Pupil-dilated · macula at the center of the field · 50° FOV · color fundus image.
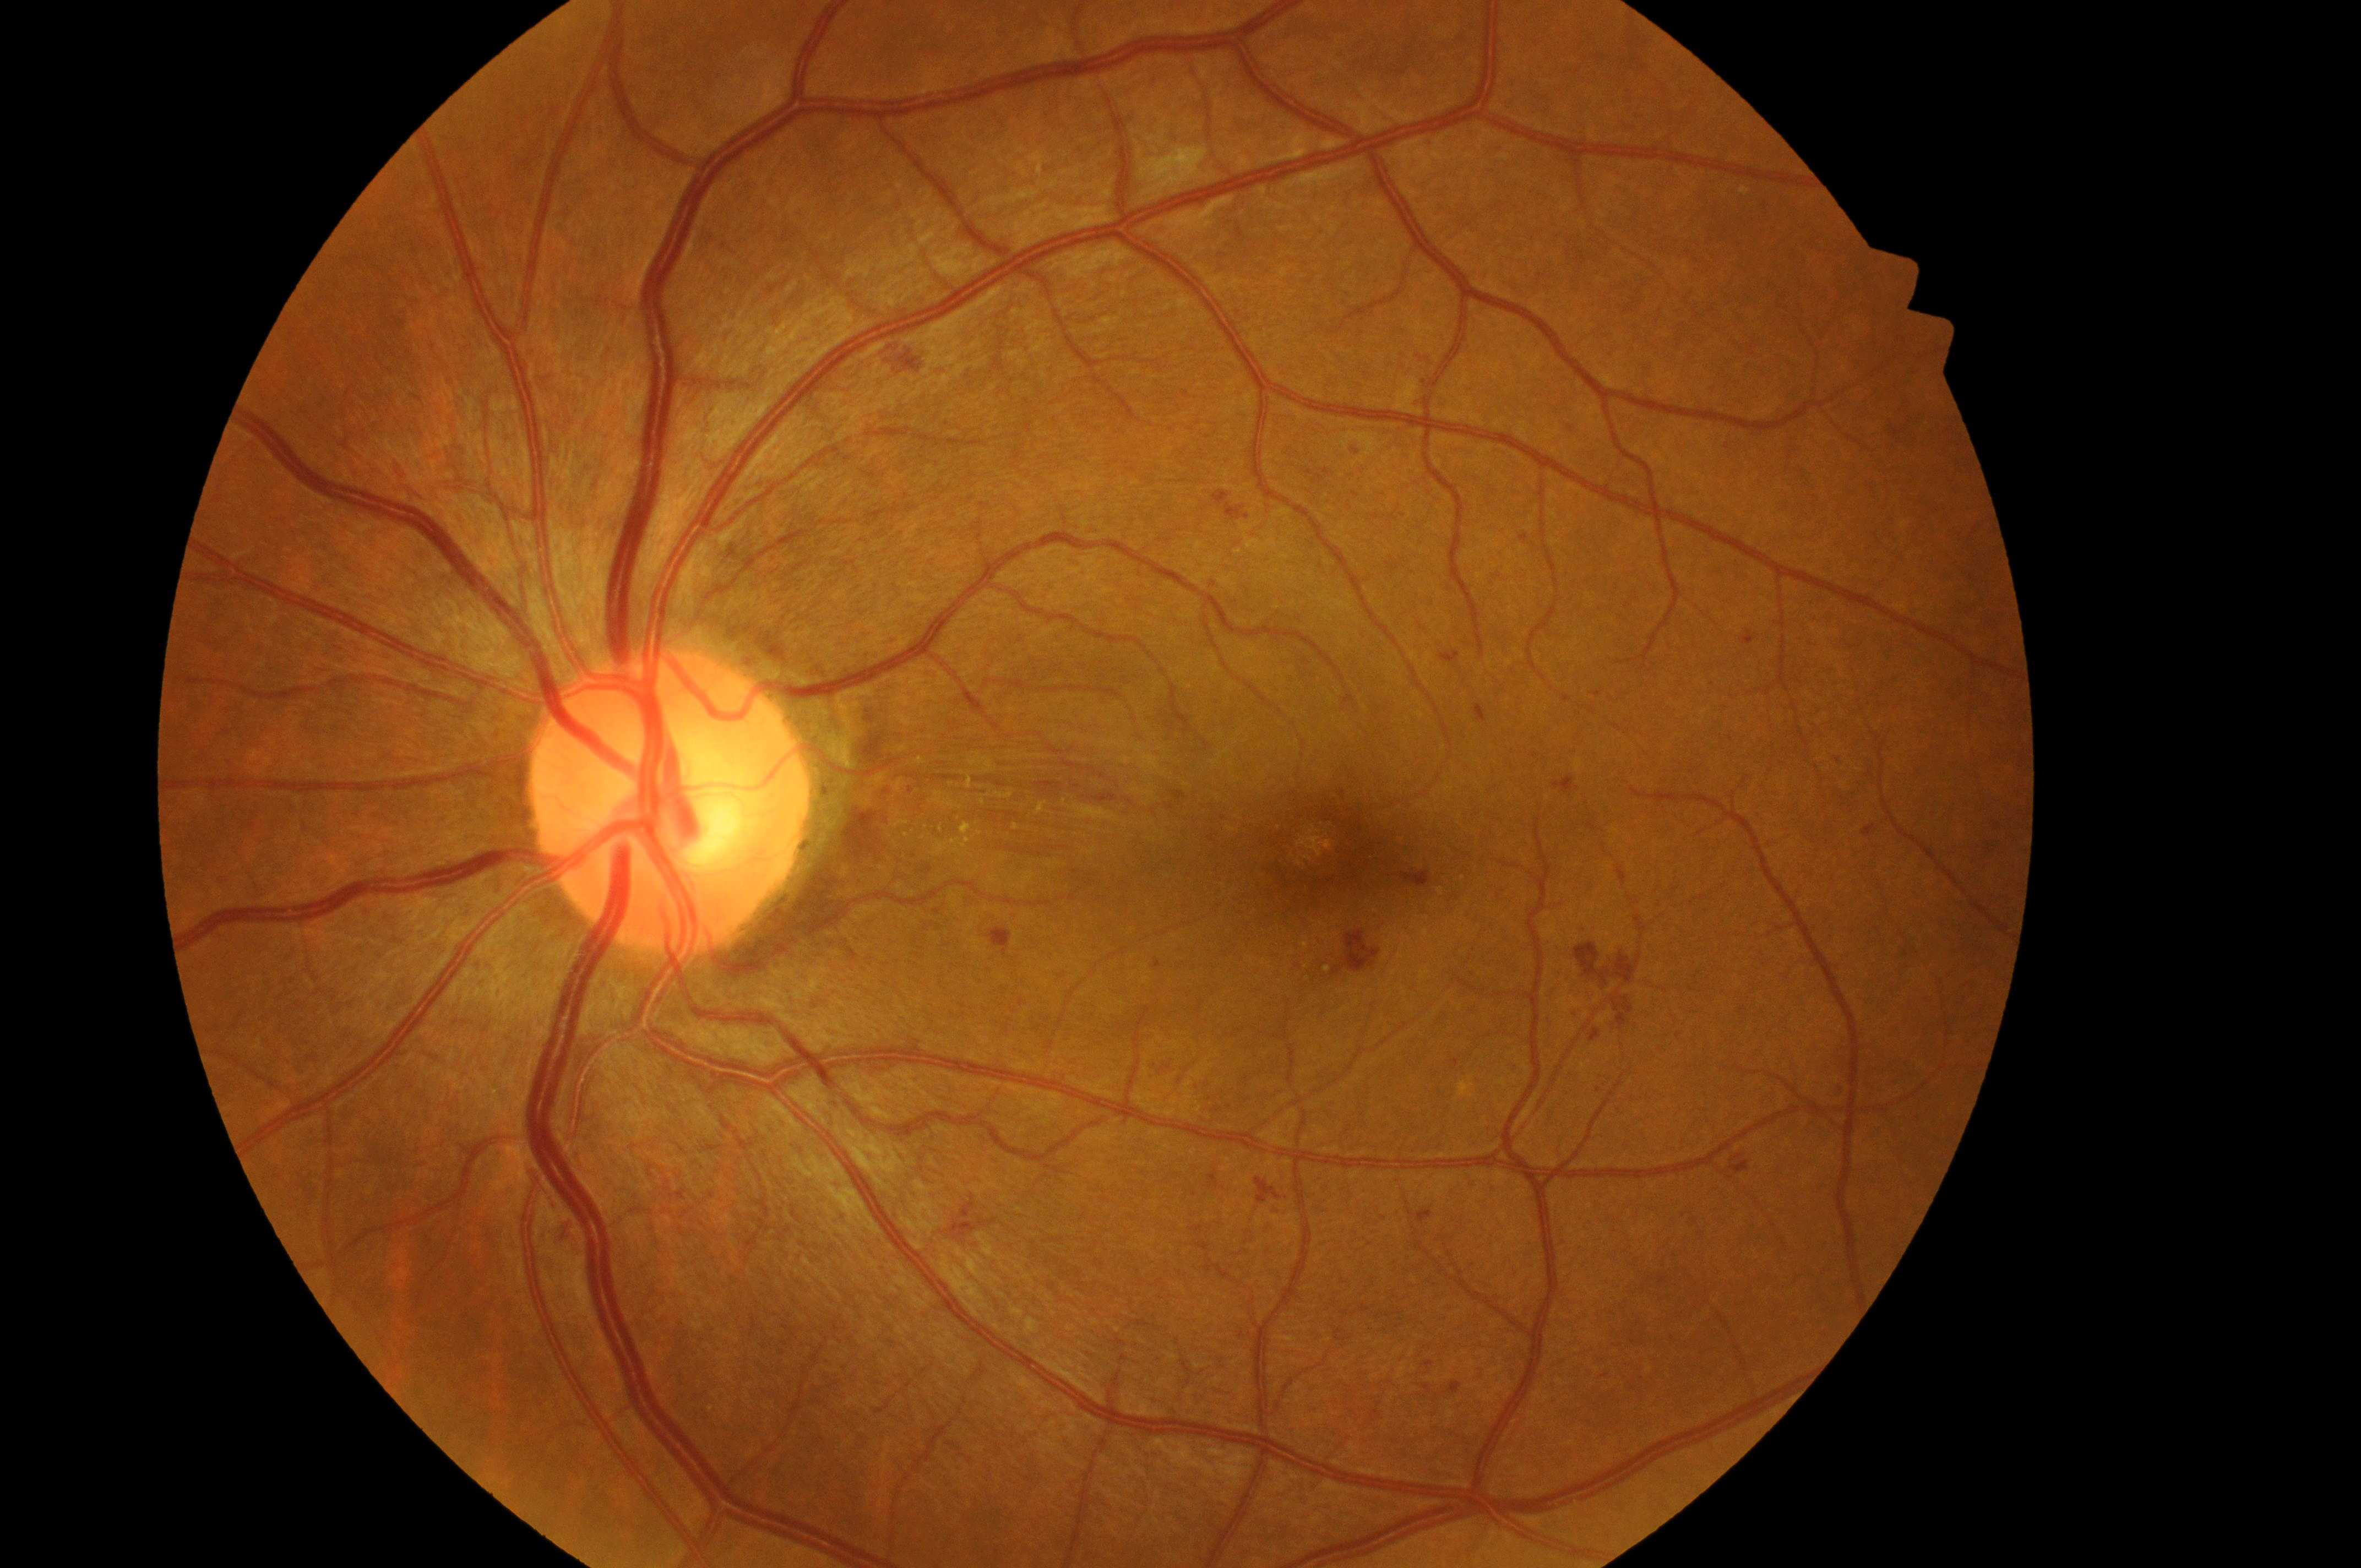

- macula center: x=1345, y=868
- laterality: left
- ONH: x=662, y=808
- DR: moderate non-proliferative diabetic retinopathy (grade 2)
- DME: high risk (grade 2)